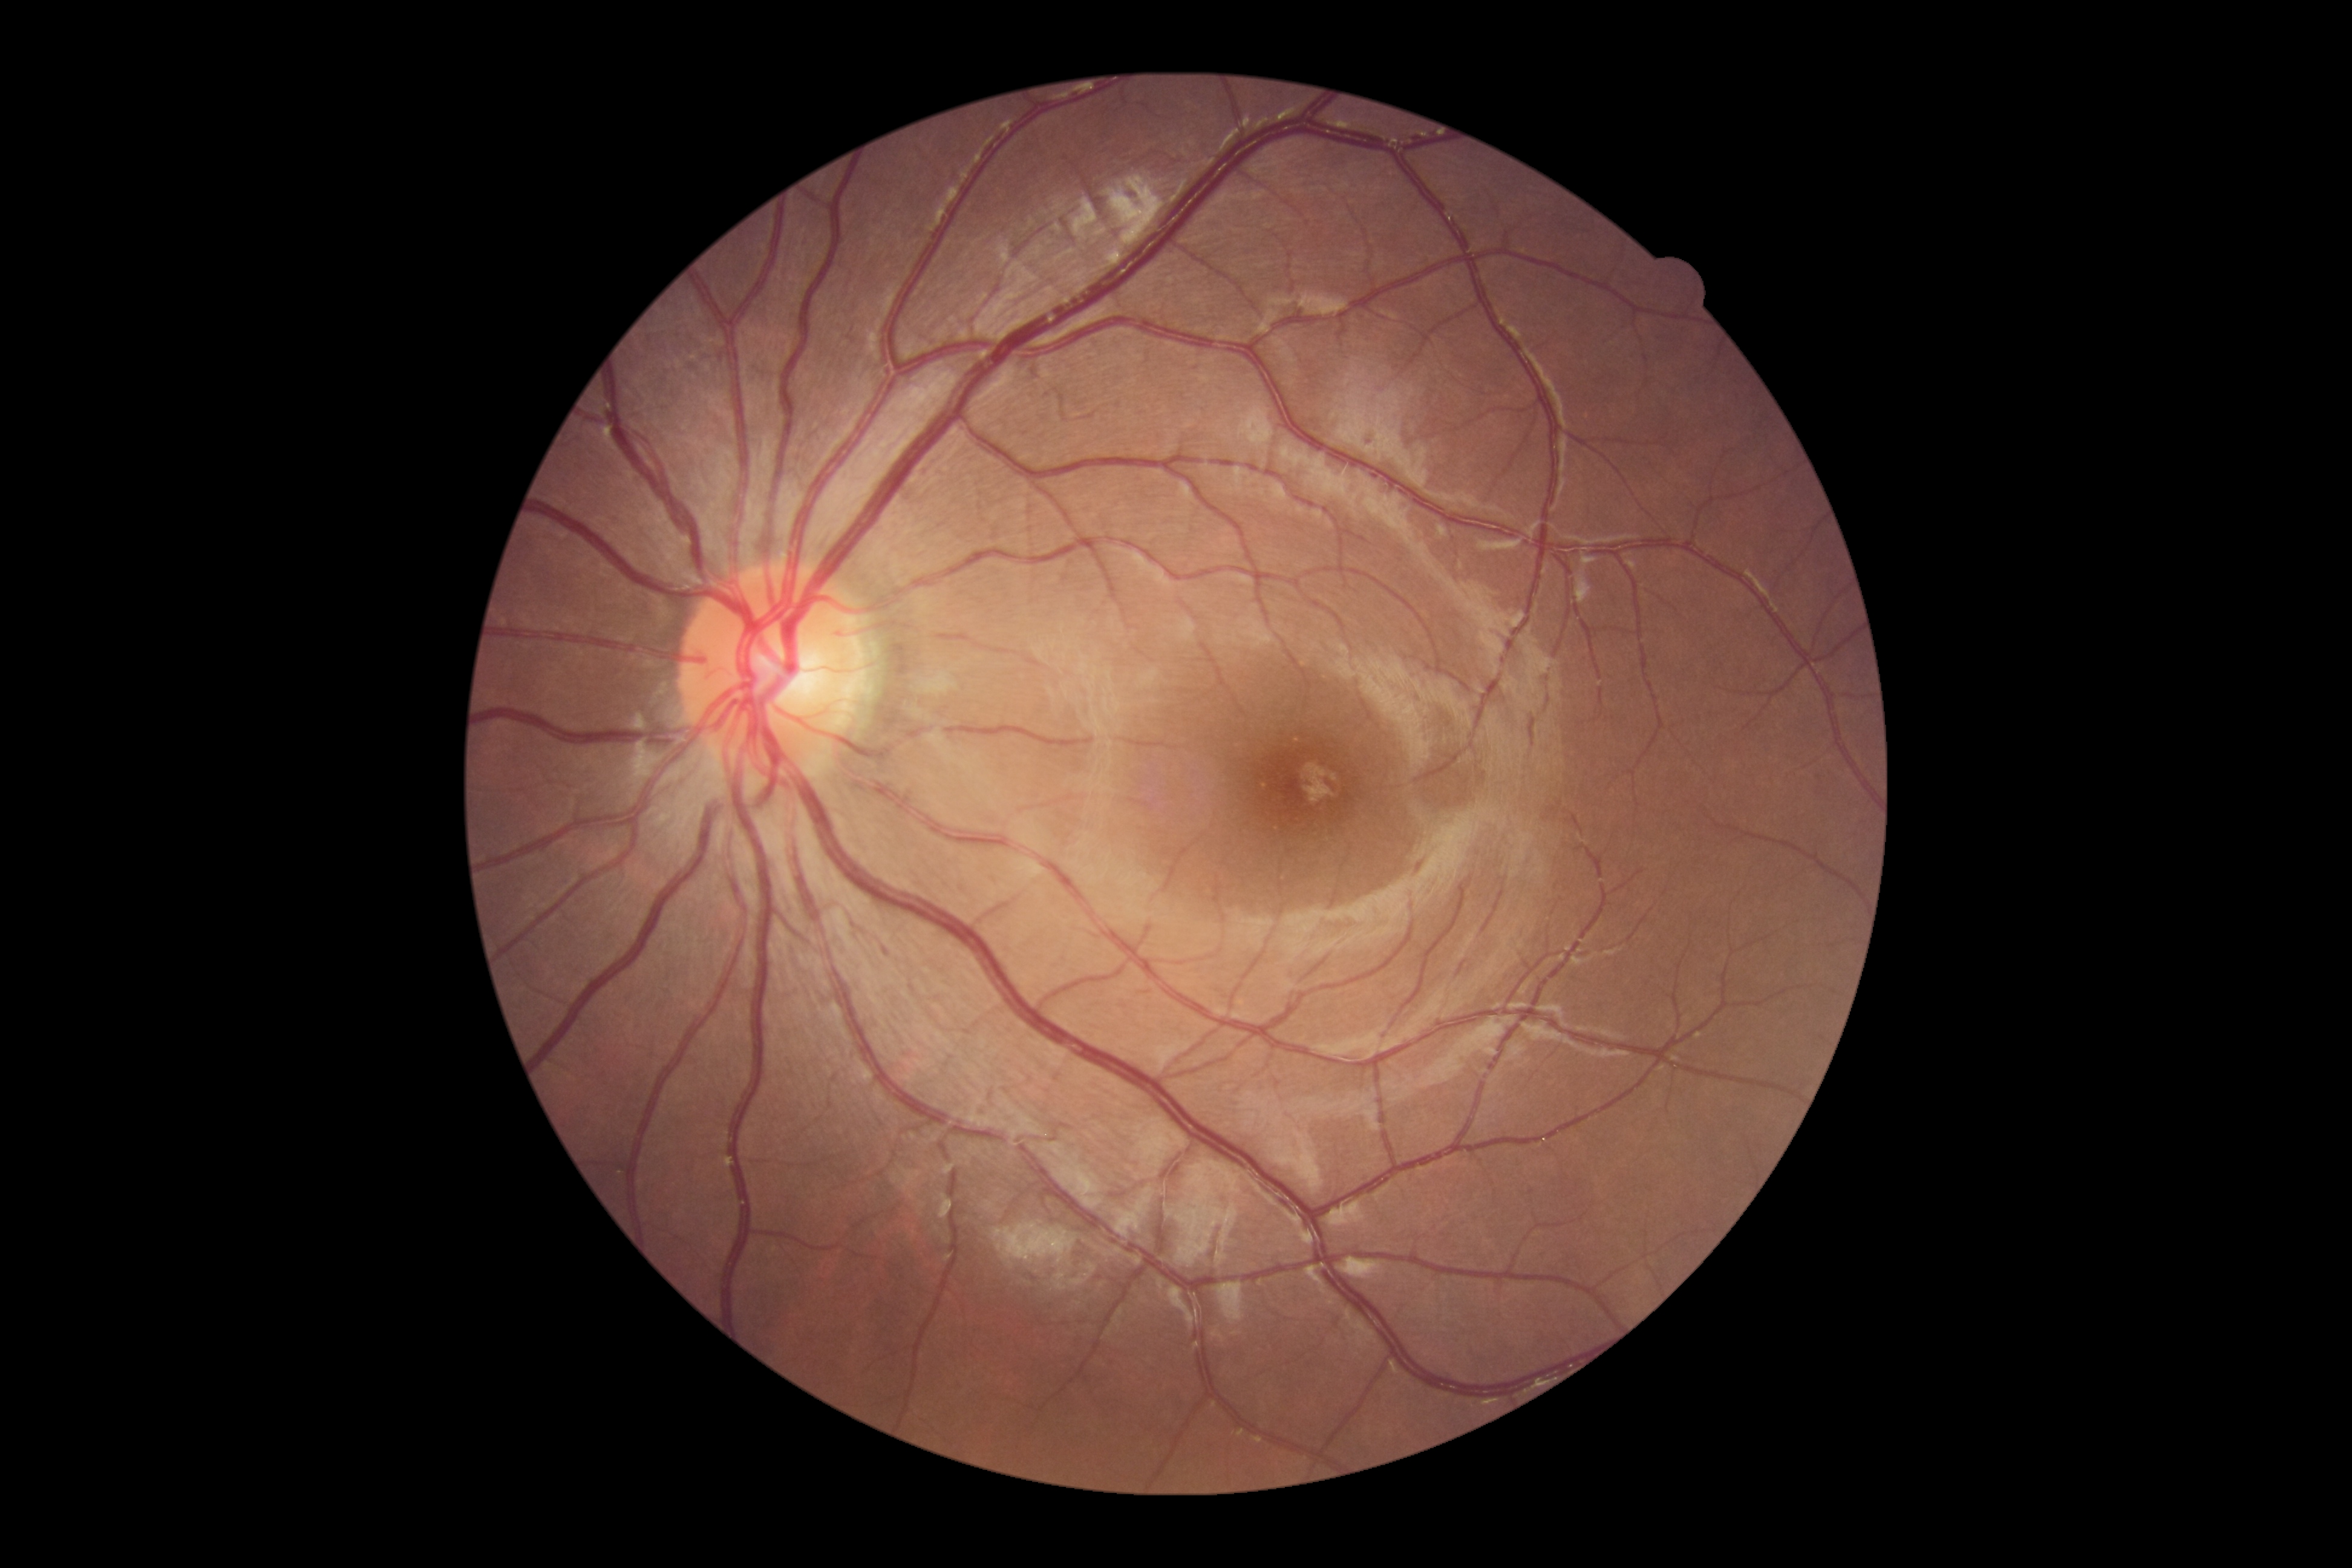 Annotations:
- DR grade — 0
- DR impression — no signs of DR